Captured with the Natus RetCam Envision (130° field of view); pediatric retinal photograph (wide-field).
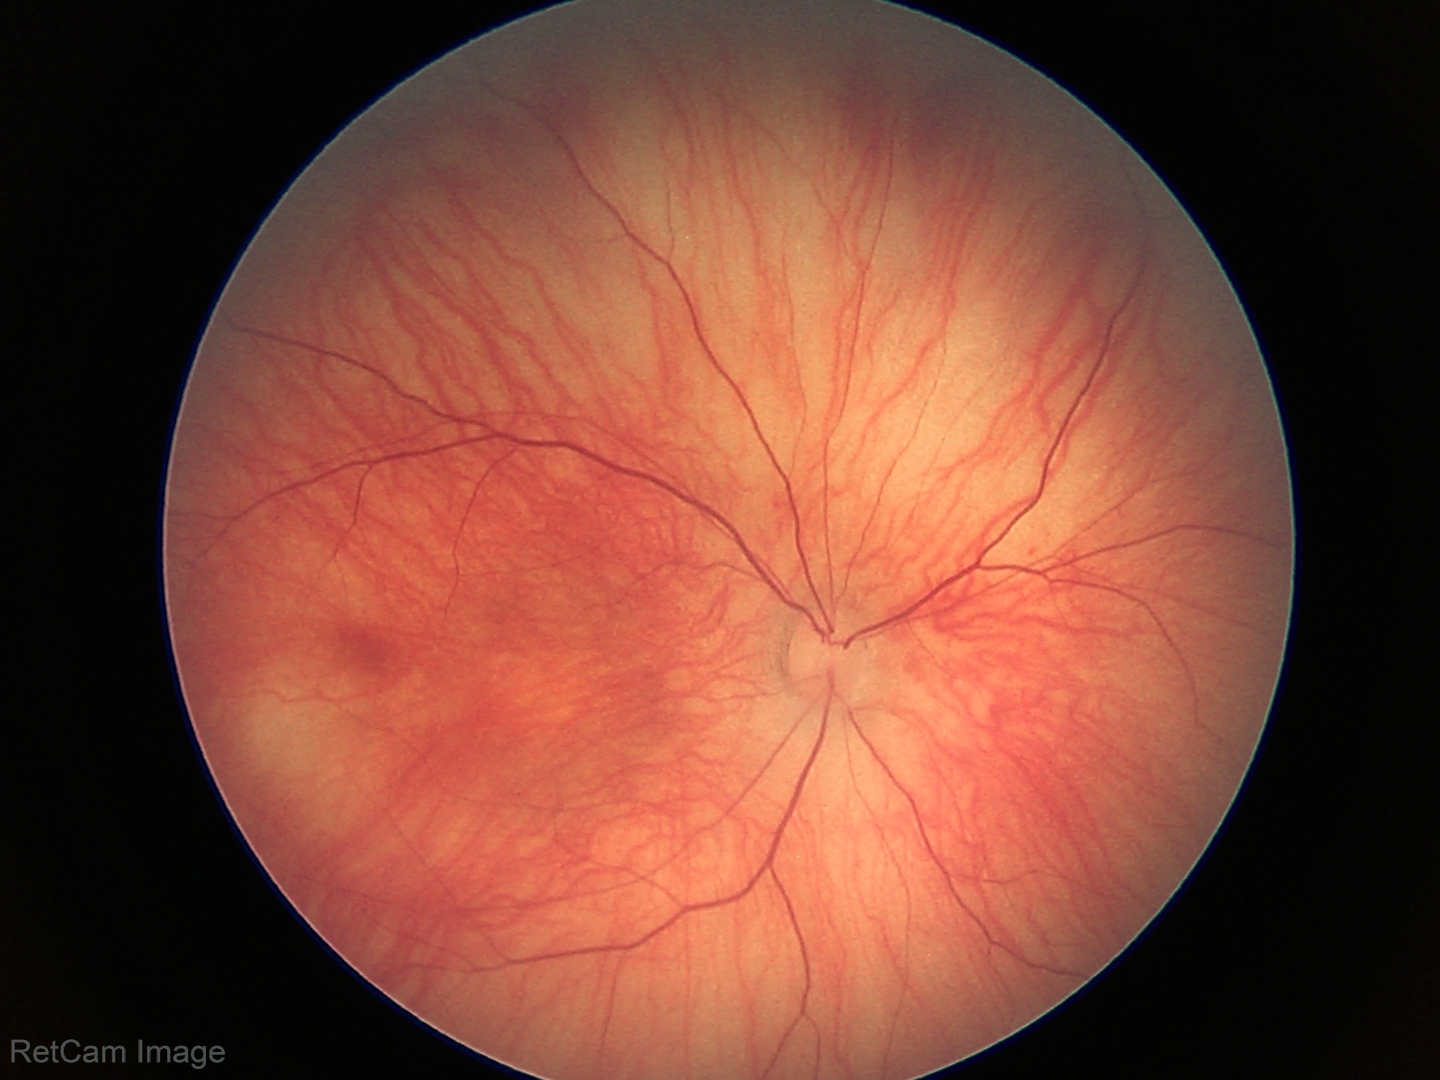

Normal screening examination.